Retinal fundus photograph
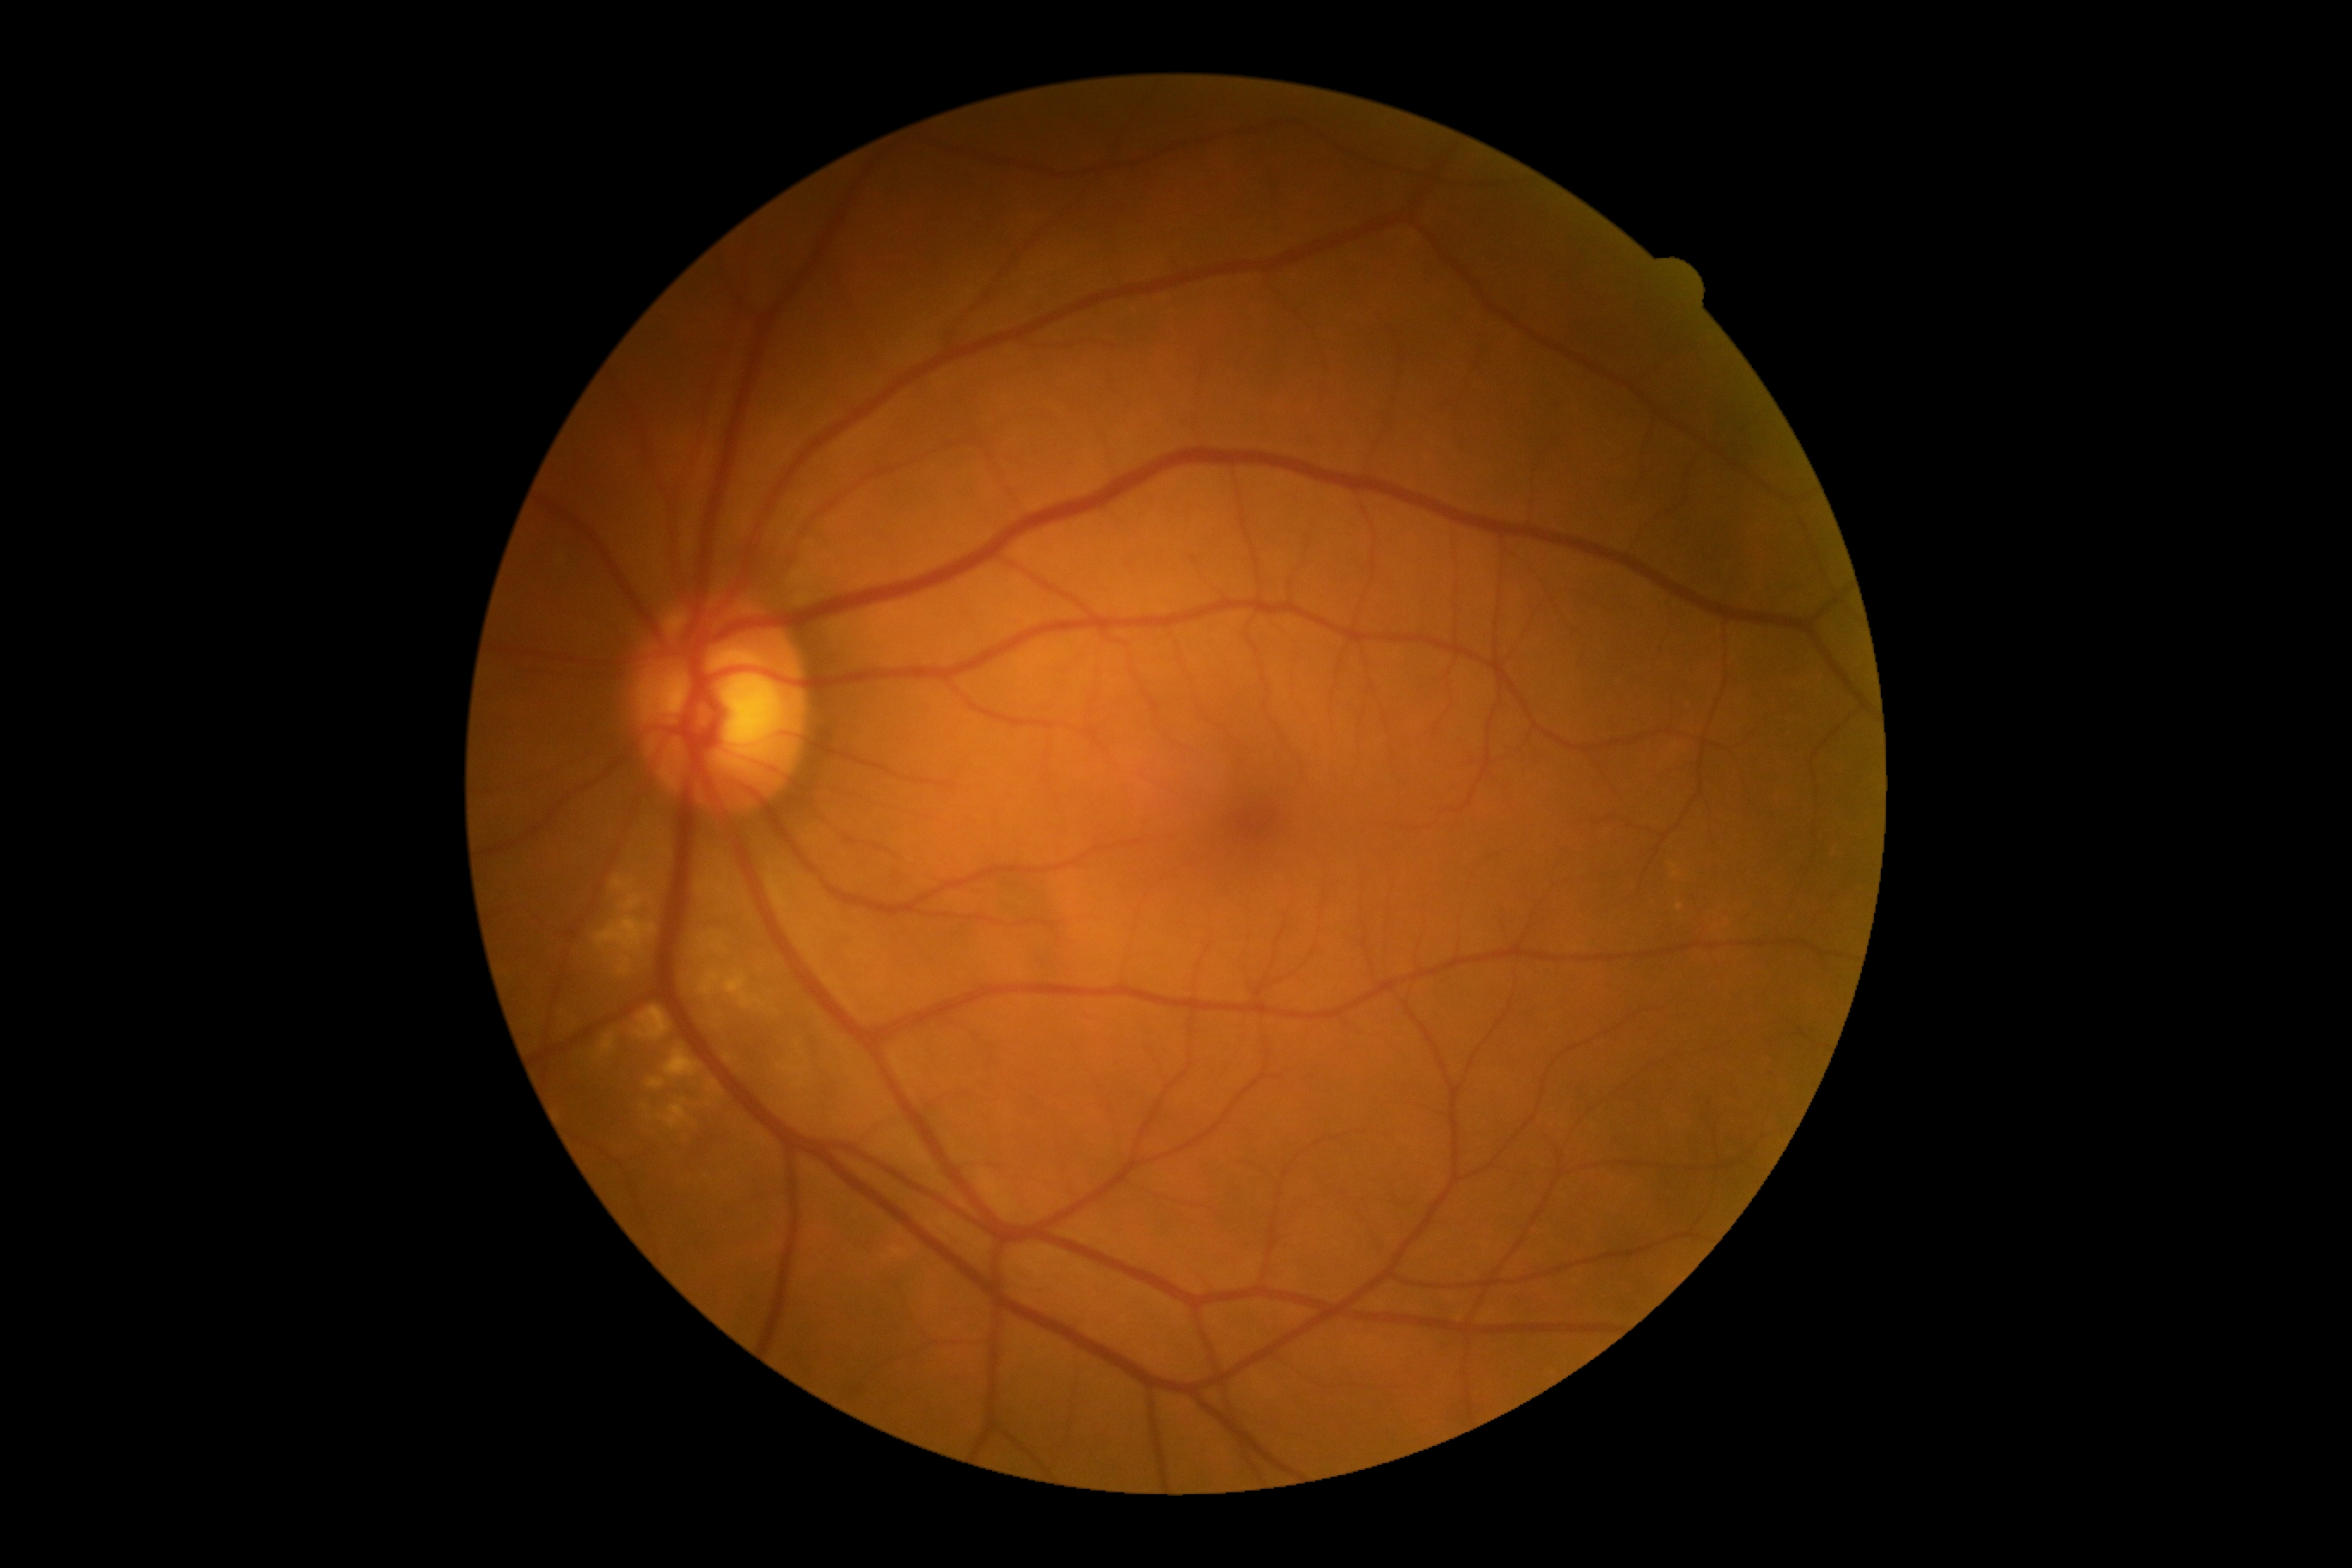 {
  "dr_grade": "0 (no apparent retinopathy)"
}